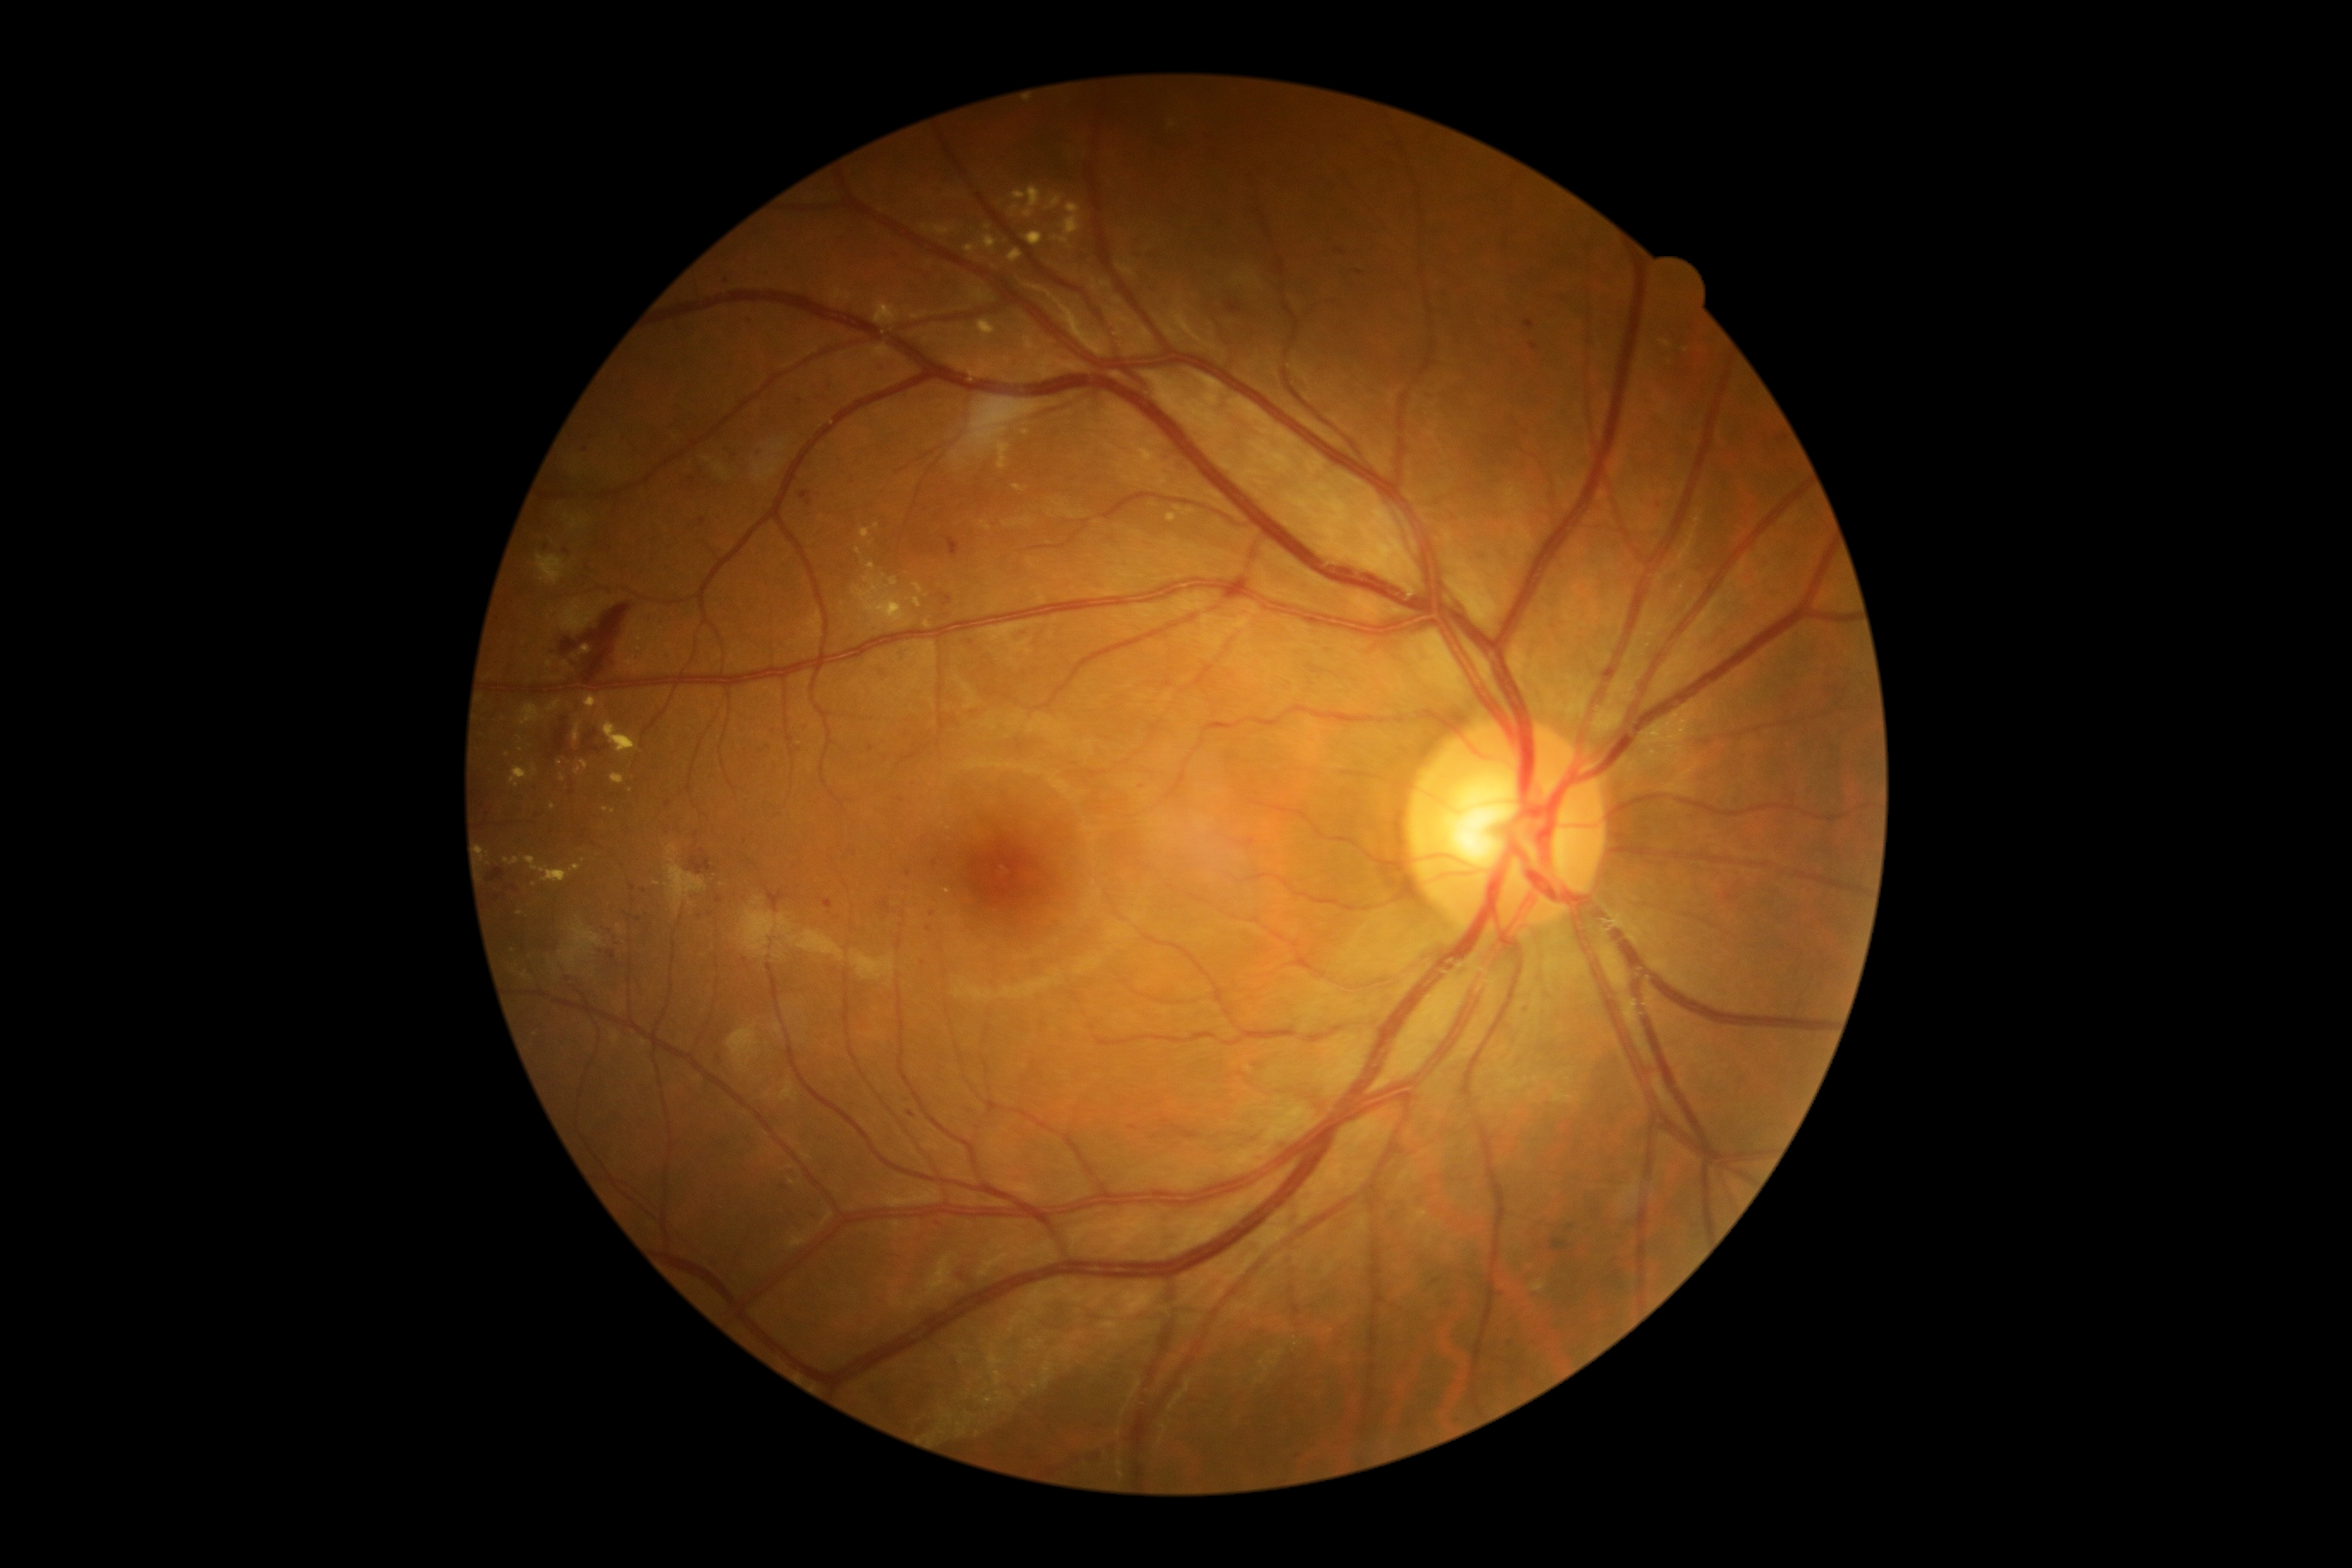
Diabetic retinopathy (DR): moderate non-proliferative diabetic retinopathy (grade 2)
A subset of detected lesions:
soft exudates (SEs): absent
hard exudates (EXs) (partial): (x1=867, y1=563, x2=876, y2=572), (x1=861, y1=529, x2=871, y2=539), (x1=1168, y1=513, x2=1177, y2=522), (x1=573, y1=723, x2=582, y2=744), (x1=989, y1=438, x2=1012, y2=470), (x1=983, y1=235, x2=998, y2=252), (x1=575, y1=761, x2=589, y2=776), (x1=852, y1=575, x2=910, y2=628), (x1=510, y1=768, x2=529, y2=788), (x1=603, y1=721, x2=639, y2=754), (x1=611, y1=775, x2=625, y2=785)
Smaller EXs around <point>876, 526</point>, <point>632, 791</point>, <point>508, 755</point>, <point>552, 807</point>, <point>859, 552</point>
microaneurysms (MAs) (partial): (x1=800, y1=491, x2=812, y2=499), (x1=1524, y1=321, x2=1534, y2=329), (x1=1552, y1=1239, x2=1569, y2=1253), (x1=1529, y1=343, x2=1540, y2=350), (x1=907, y1=1110, x2=916, y2=1118)
Smaller MAs around <point>809, 502</point>, <point>1341, 252</point>, <point>784, 1187</point>, <point>566, 551</point>, <point>496, 898</point>, <point>1155, 1138</point>, <point>538, 816</point>, <point>769, 747</point>, <point>585, 449</point>, <point>639, 919</point>, <point>1142, 788</point>, <point>719, 900</point>, <point>633, 888</point>, <point>932, 914</point>
hemorrhages (HEs): (x1=487, y1=869, x2=505, y2=883), (x1=489, y1=893, x2=499, y2=902), (x1=946, y1=537, x2=962, y2=558), (x1=561, y1=639, x2=579, y2=656), (x1=580, y1=604, x2=632, y2=680), (x1=544, y1=716, x2=604, y2=771), (x1=690, y1=857, x2=711, y2=874), (x1=1227, y1=300, x2=1242, y2=314)